Fundus photo: 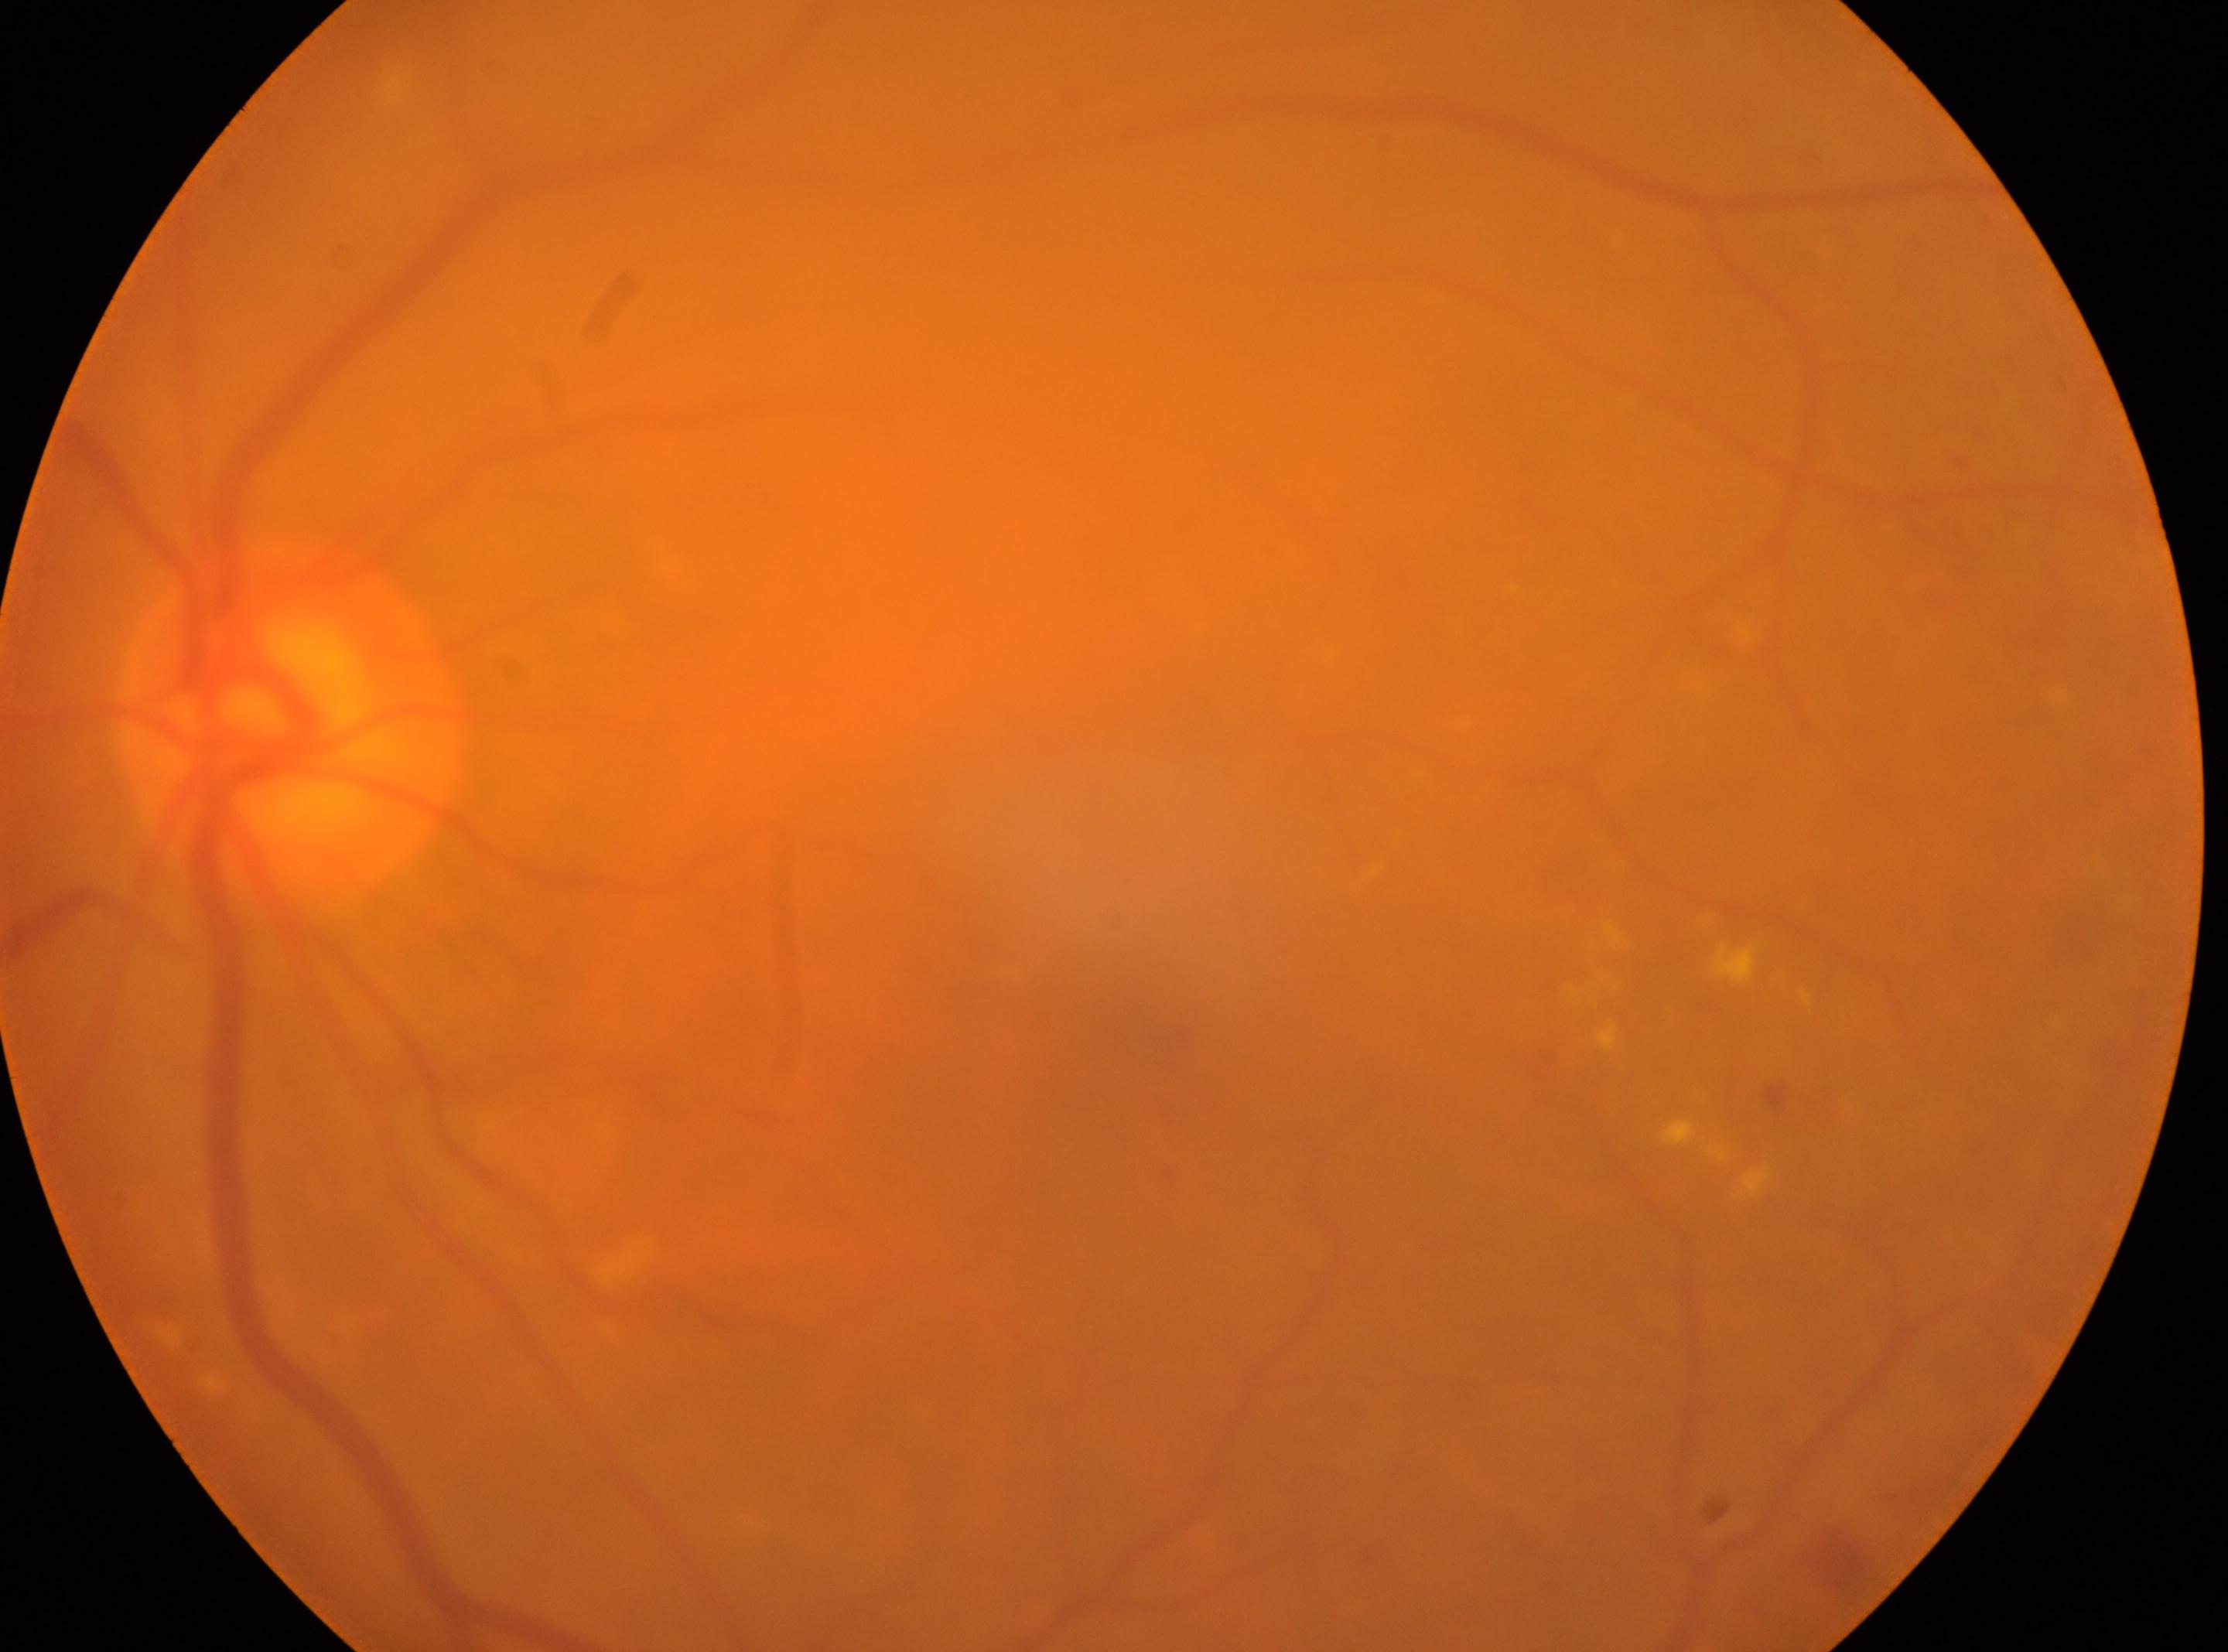

Optic disc: x=294, y=723.
This is the oculus sinister.
The macula center is at x=1157, y=1044.
DR is 2.